2361x1568px; Kowa VX-10α; pupil-dilated; 50-degree field of view: 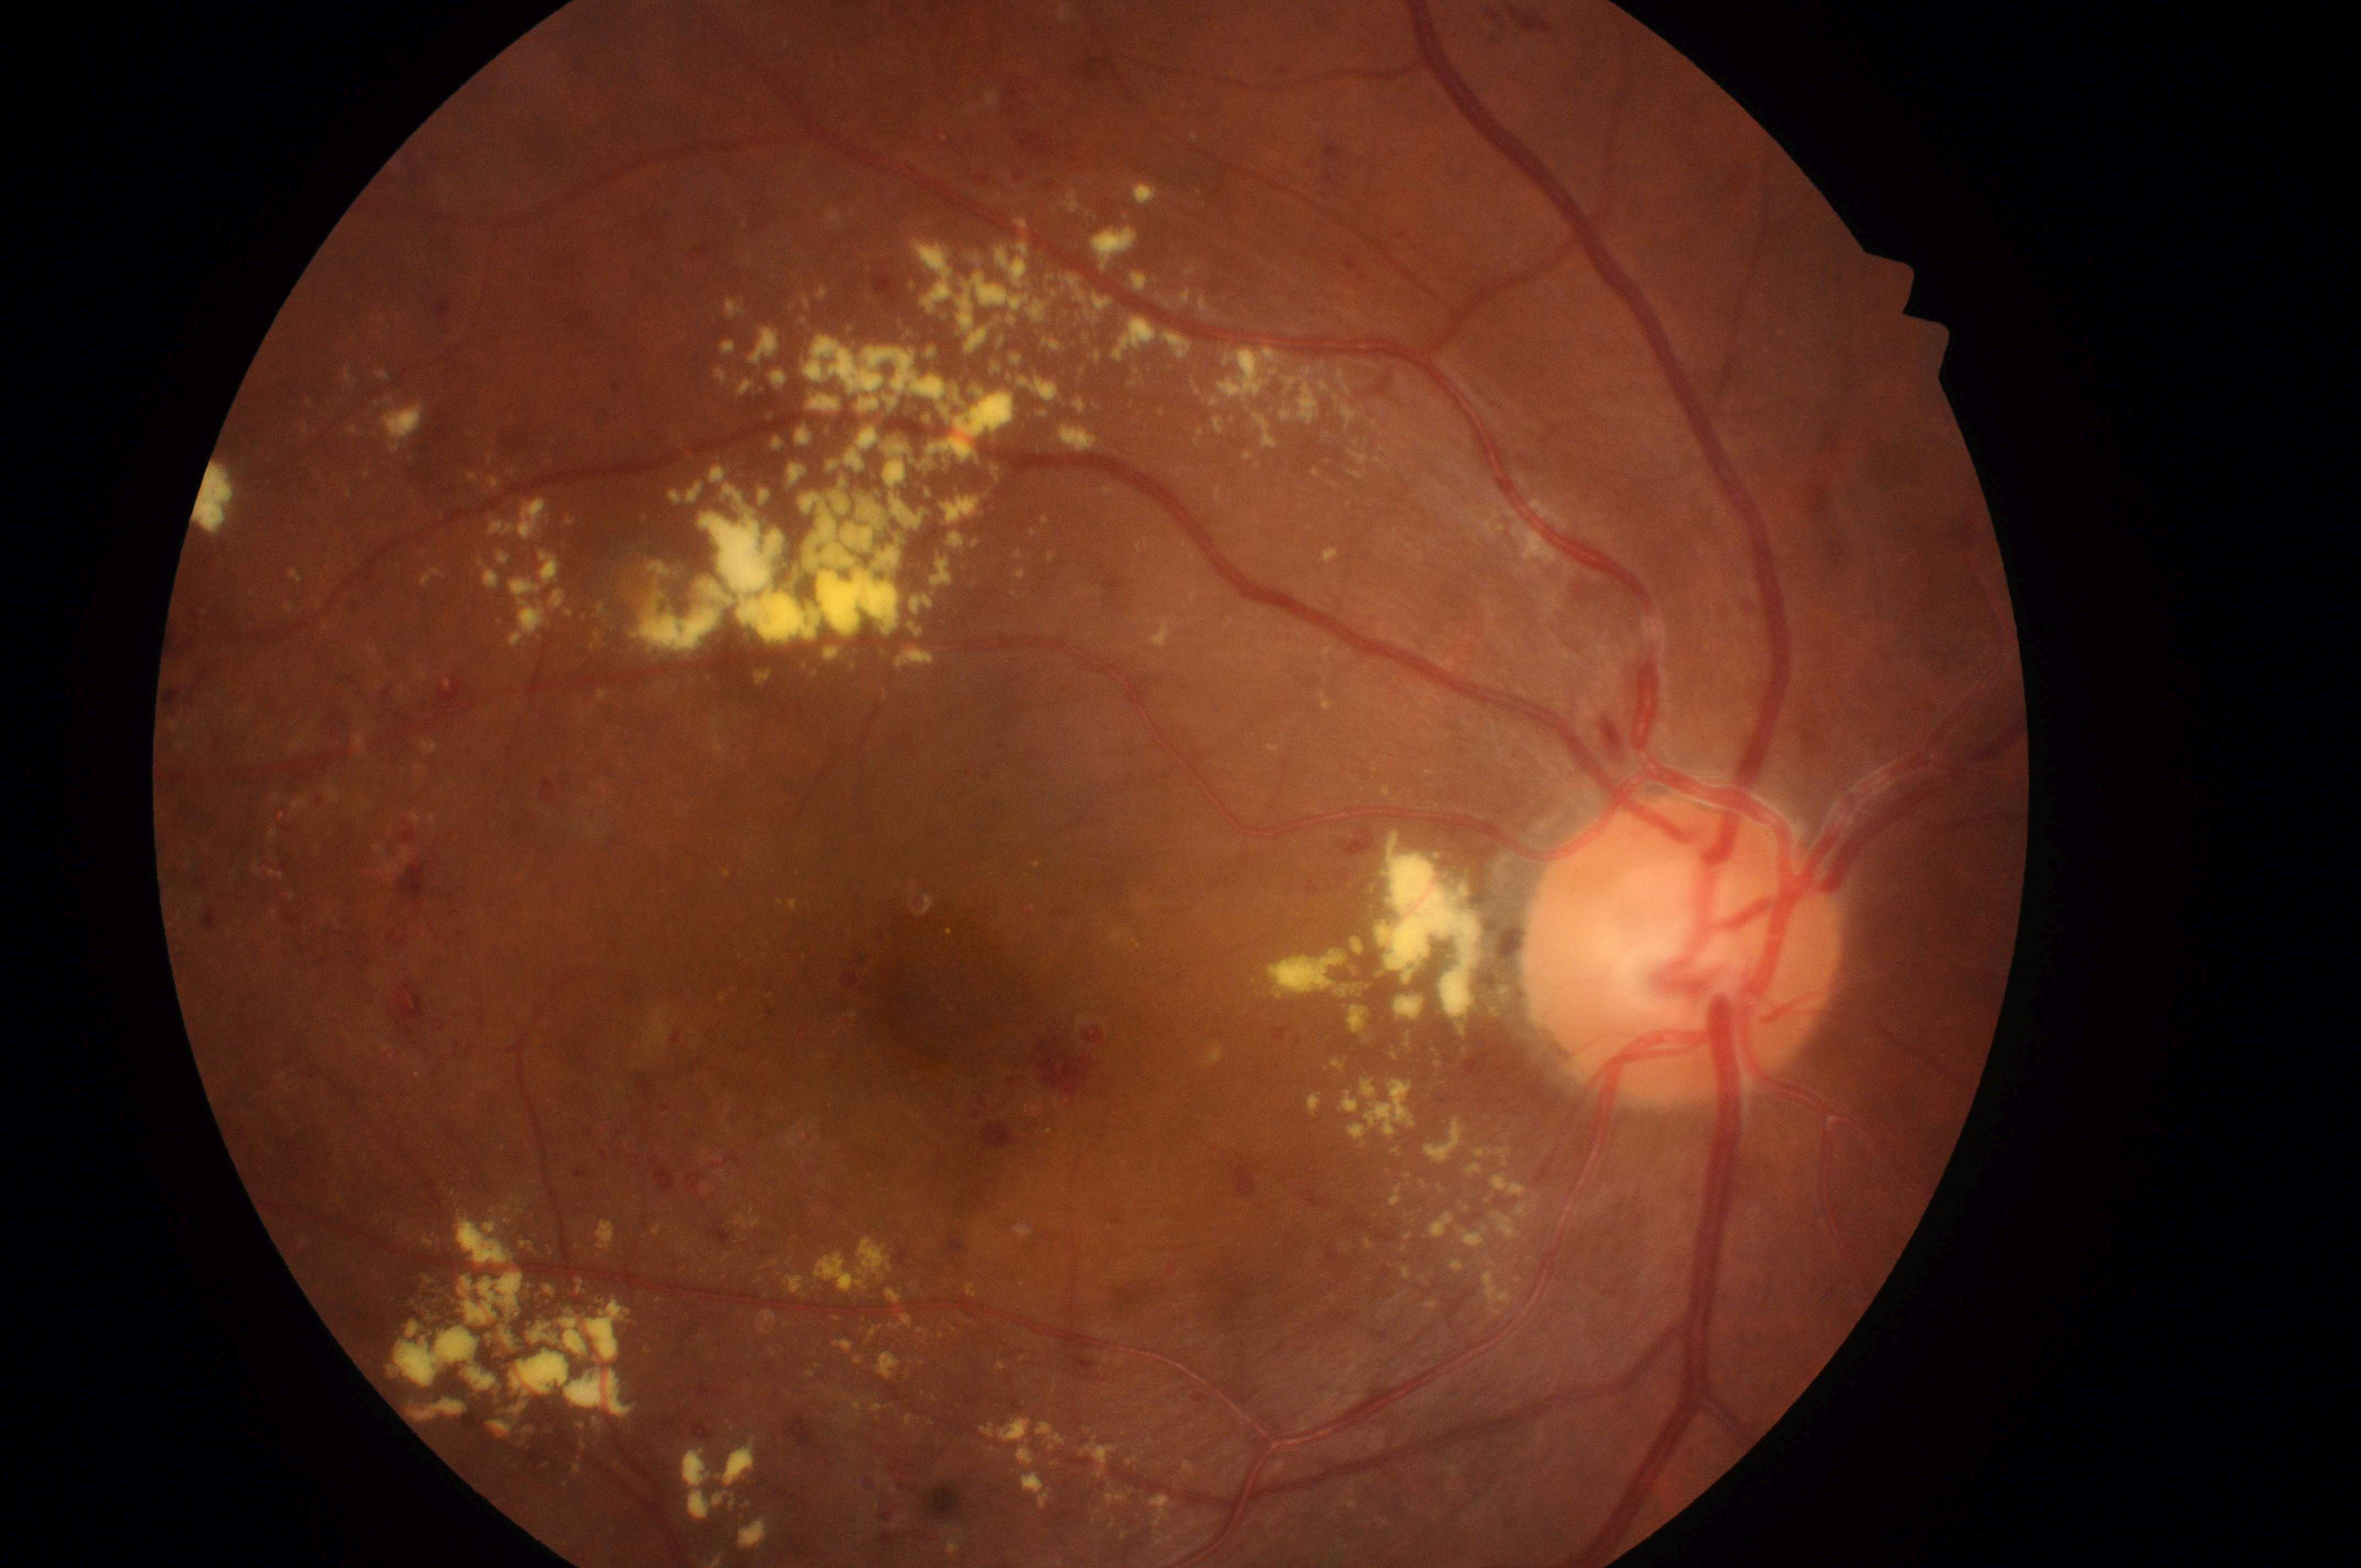 Annotations:
* disc center: 1681px, 961px
* macular edema: 2 — hard exudates within one disc diameter of the macula center
* the fovea: 901px, 1012px
* laterality: right eye
* retinopathy: grade 3 — more than 20 intraretinal hemorrhages in each of 4 quadrants, definite venous beading in 2 or more quadrants, or prominent intraretinal microvascular abnormalities in 1 or more quadrants, with no signs of proliferative retinopathy
* DR class: non-proliferative diabetic retinopathy